Fundus photo. FOV: 45 degrees:
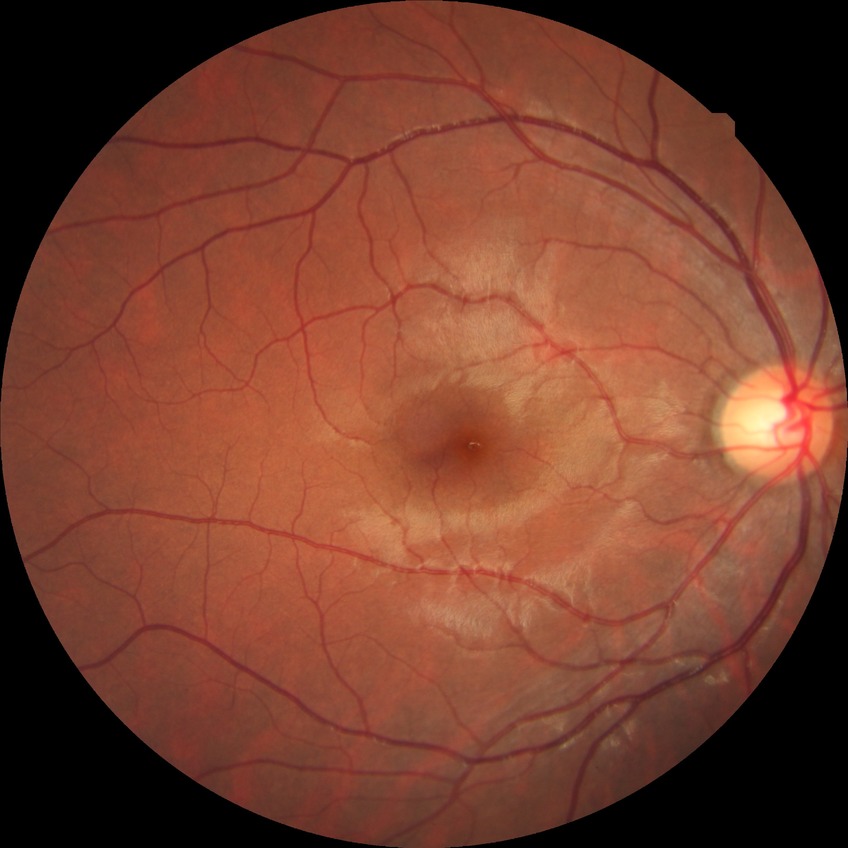
modified Davis grading=no diabetic retinopathy.